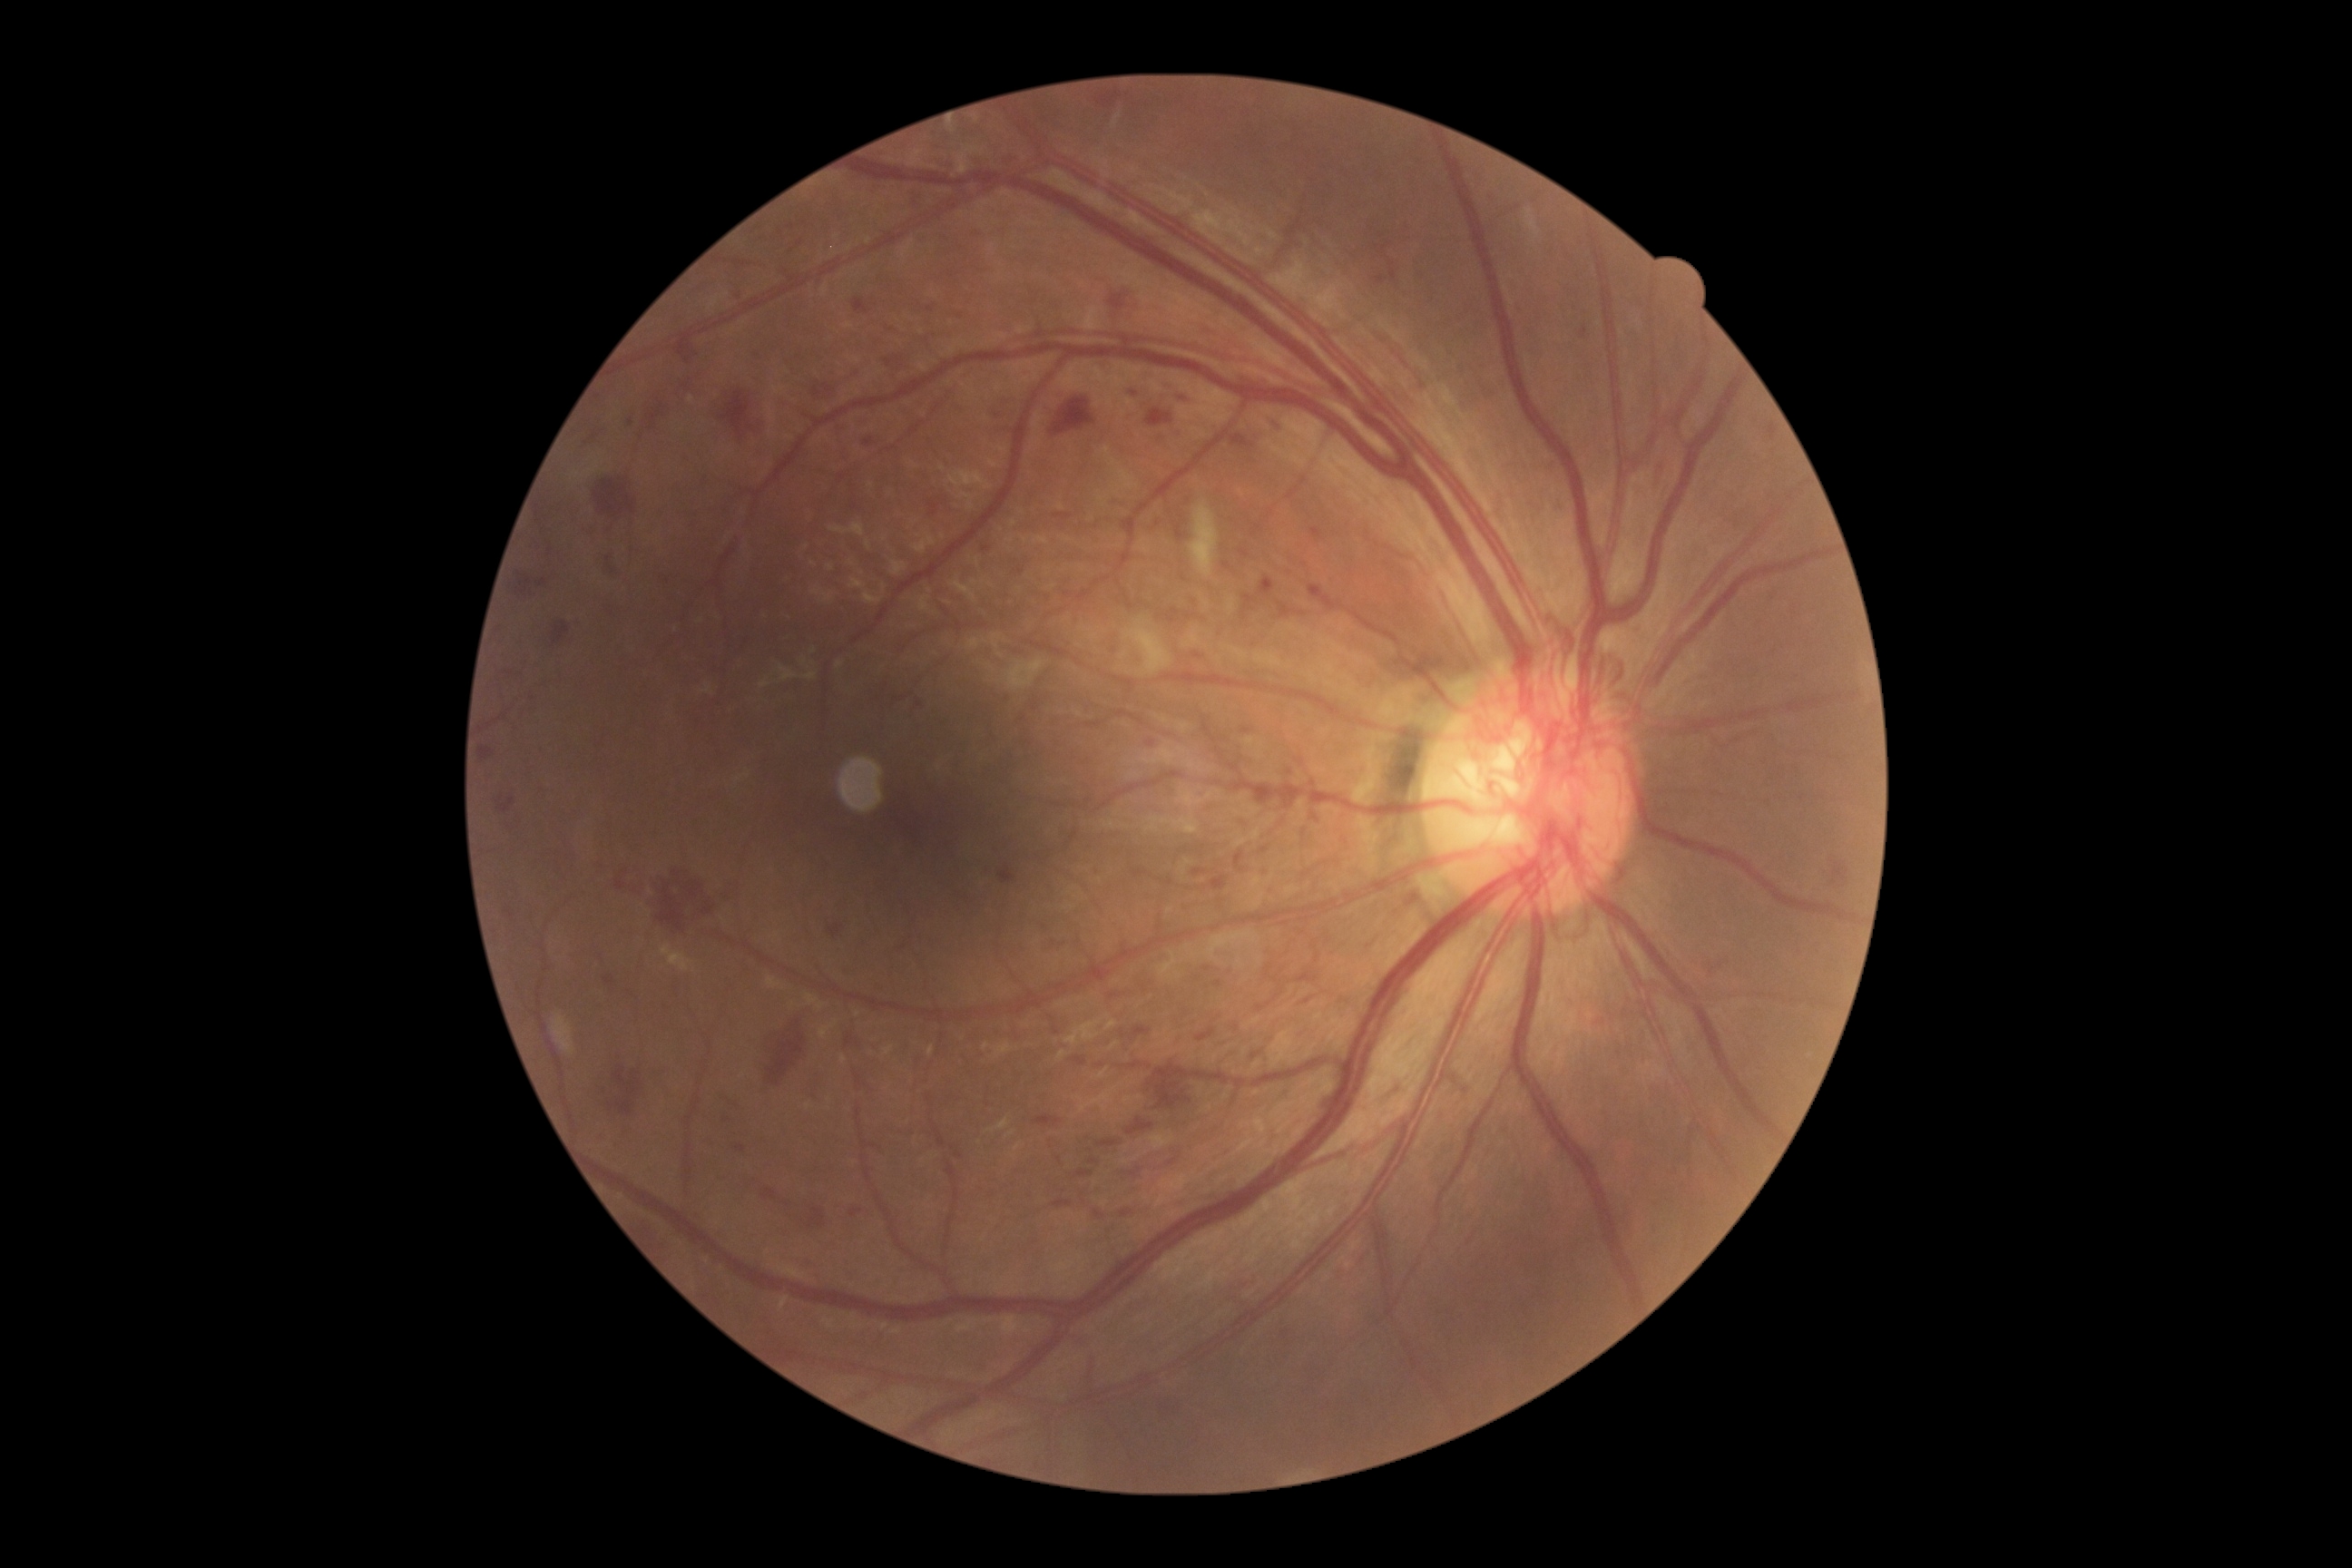
DR grade is 4 (PDR) — neovascularization and/or vitreous/pre-retinal hemorrhage. HEs include <region>1230, 435, 1255, 447</region>, <region>678, 338, 696, 362</region>, <region>1193, 652, 1202, 660</region>, <region>845, 1034, 861, 1048</region>, <region>1260, 416, 1284, 436</region>, <region>1652, 453, 1661, 493</region>, <region>850, 1208, 863, 1219</region>, <region>1146, 409, 1175, 429</region>, <region>1148, 1064, 1188, 1110</region>, <region>1375, 275, 1387, 286</region>, <region>1133, 1028, 1152, 1039</region>, <region>1075, 1170, 1093, 1179</region>, <region>1308, 585, 1344, 611</region>, <region>1088, 1159, 1101, 1166</region>, <region>482, 747, 495, 763</region>, <region>1769, 424, 1778, 440</region>, <region>1197, 1028, 1217, 1043</region>, <region>1184, 612, 1197, 622</region>. HEs (small, approximate centers) near x=1021, y=571.